Corneal thickness 516 µm · color fundus photograph · 78-year-old patient · IOP (non-contact tonometry): 18 mmHg.
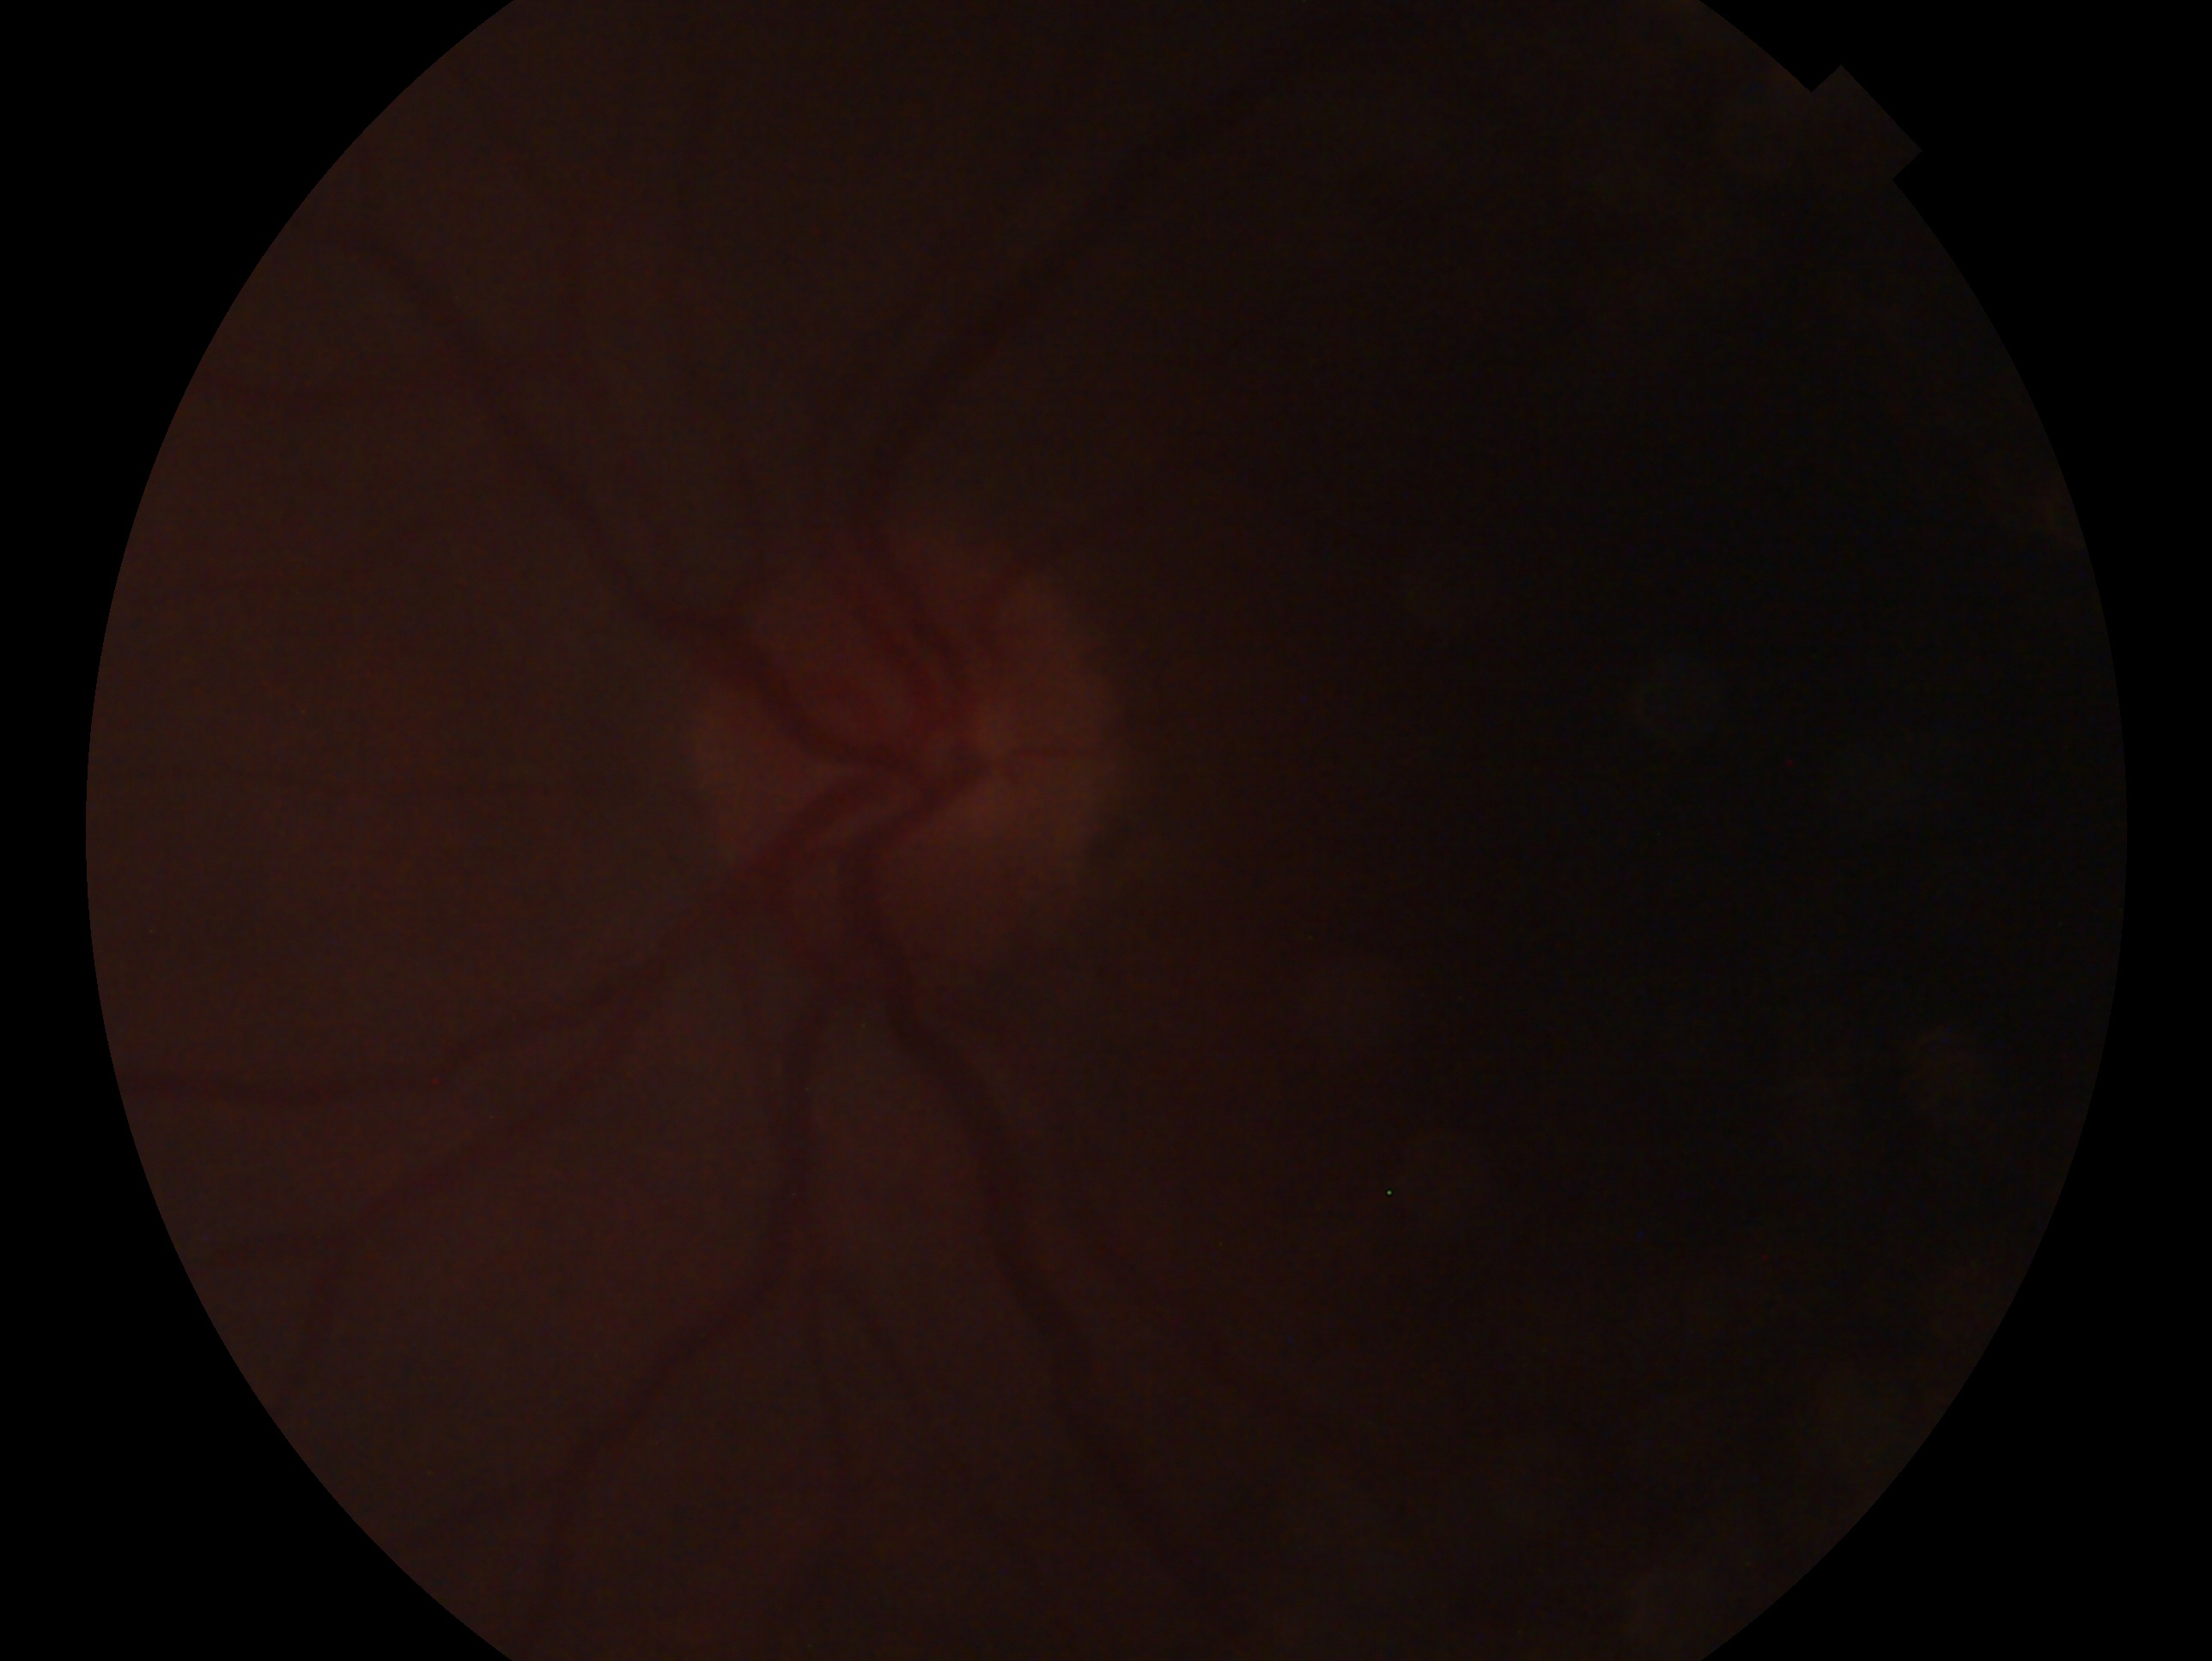 laterality: left eye | clinical classification: glaucoma cannot be excluded.